Wide-field fundus photograph from neonatal ROP screening: 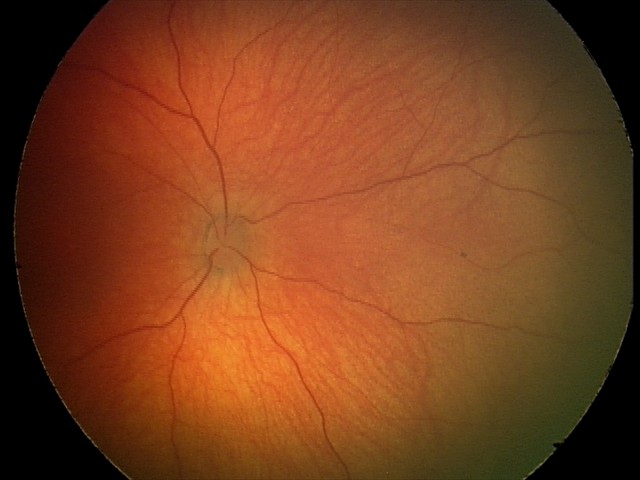 Normal screening examination.